Infant wide-field fundus photograph:
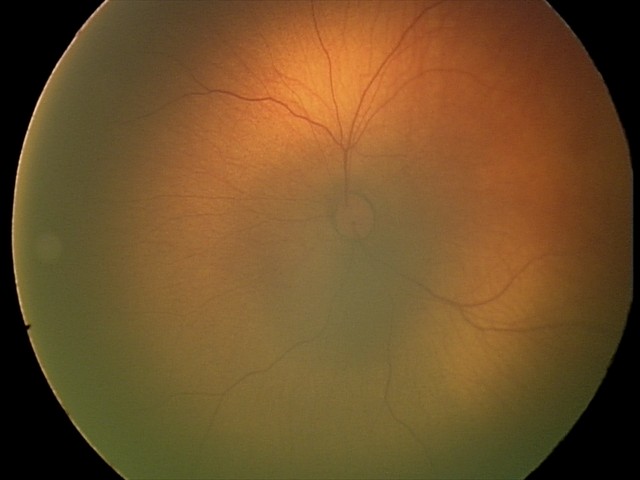

No retinal pathology identified on screening.